Pediatric retinal photograph (wide-field) — 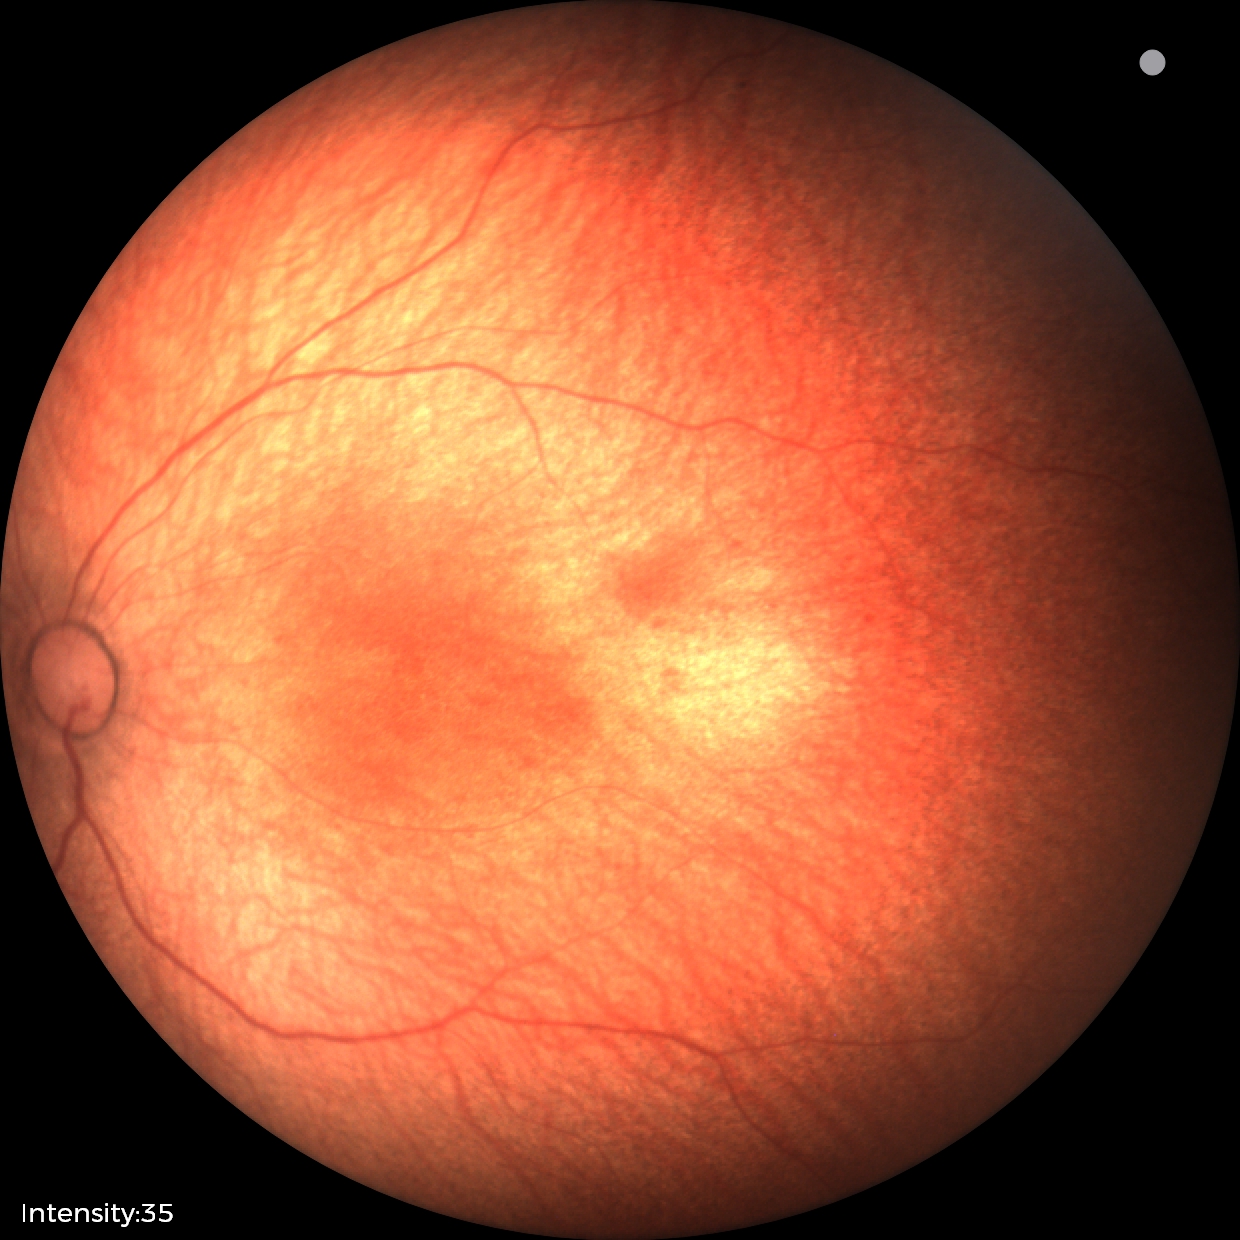
Physiological retinal appearance for postconceptual age.